FOV: 45 degrees, camera: NIDEK AFC-230 — 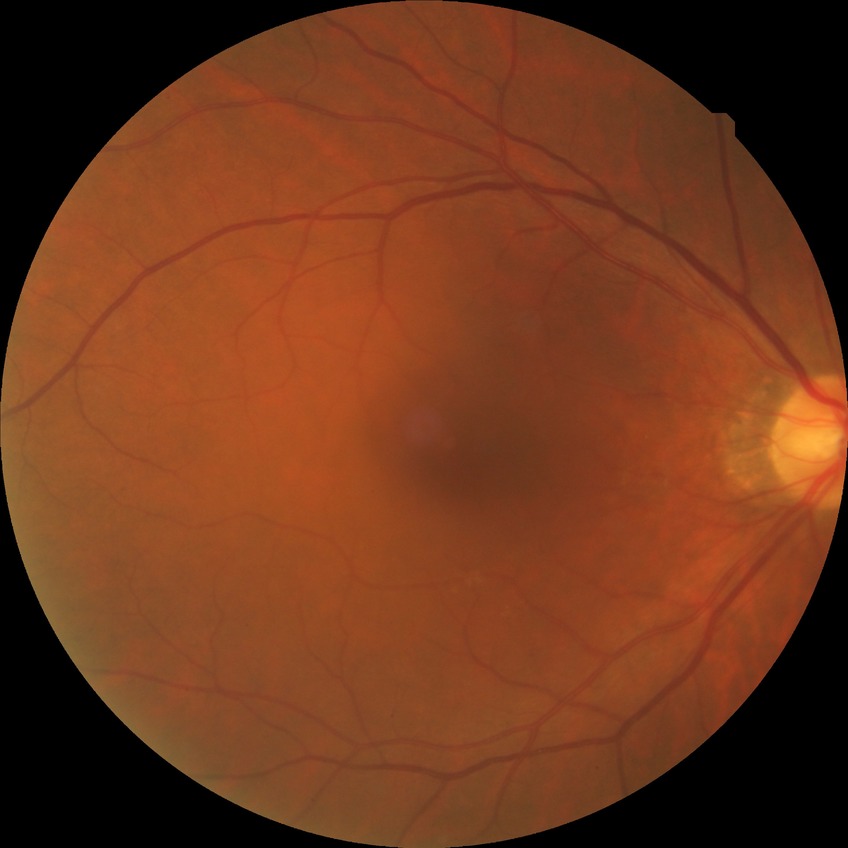 Findings:
• diabetic retinopathy (DR): no diabetic retinopathy (NDR)